2048 by 1536 pixels. 45° FOV. CFP — 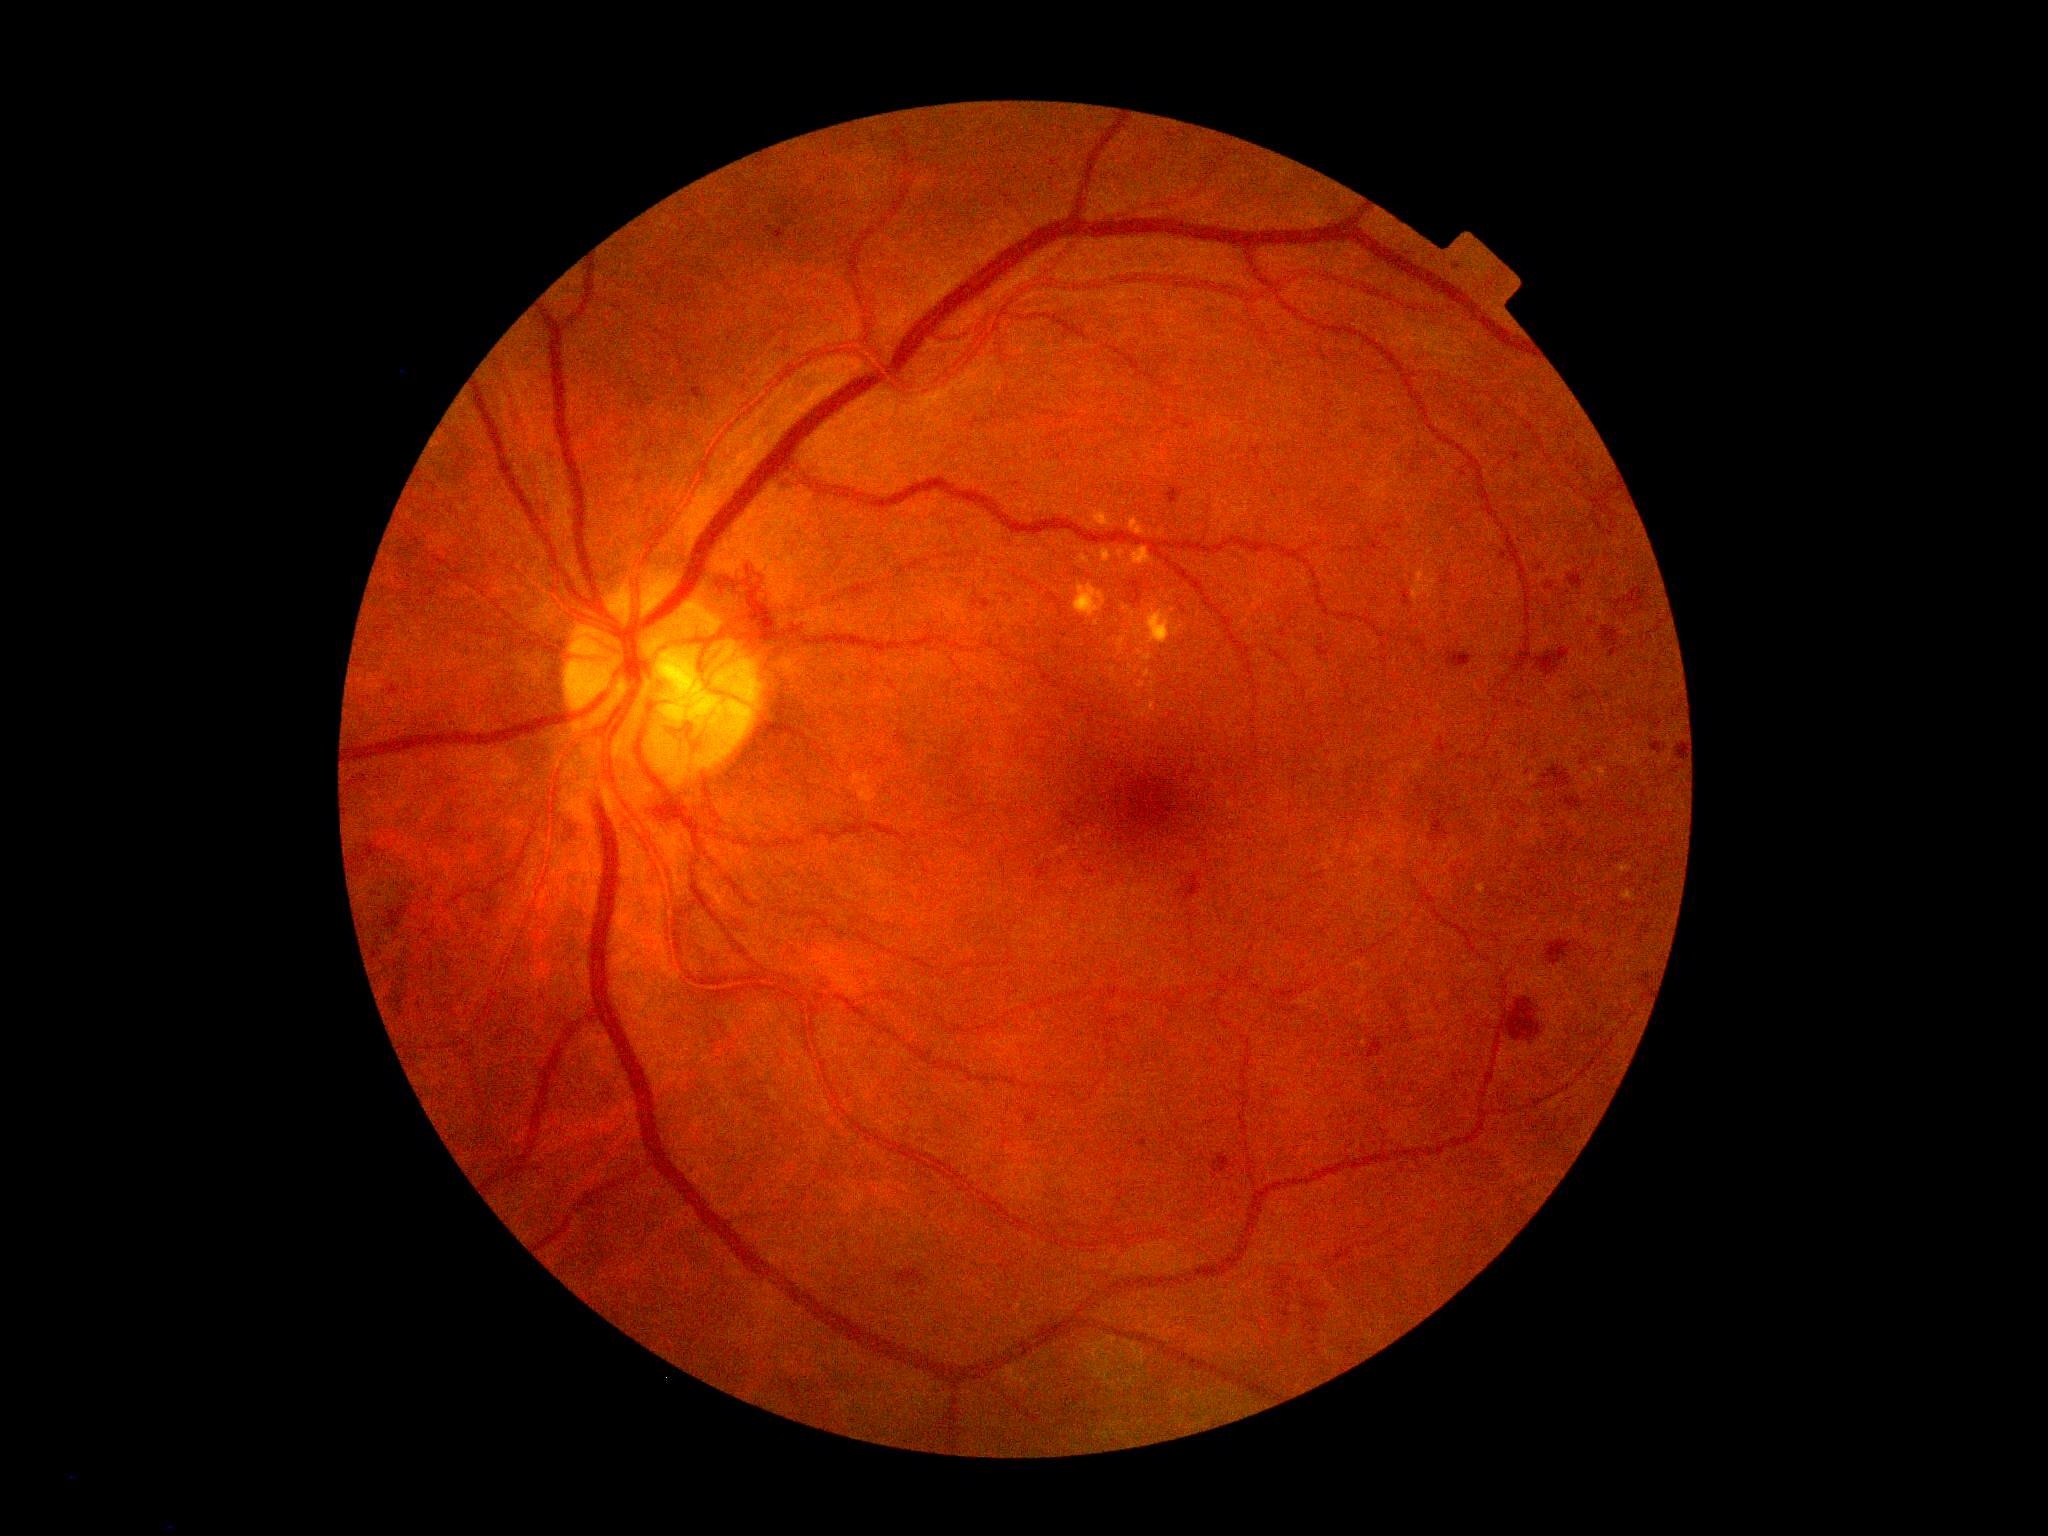 DR grade: 4 (PDR). HEs (partial list) at l=1403, t=591, r=1410, b=606, l=779, t=478, r=799, b=500, l=1566, t=798, r=1579, b=808, l=968, t=596, r=992, b=612, l=1679, t=743, r=1685, b=759, l=1544, t=767, r=1570, b=788, l=898, t=1271, r=918, b=1283, l=1603, t=628, r=1618, b=639, l=1546, t=583, r=1554, b=590, l=1434, t=820, r=1445, b=834, l=1219, t=1155, r=1230, b=1173, l=1624, t=588, r=1643, b=608, l=1536, t=648, r=1570, b=676. HEs (small, approximate centers) near pt(1527, 772), pt(1546, 784), pt(1144, 1143), pt(1644, 982), pt(1462, 756).